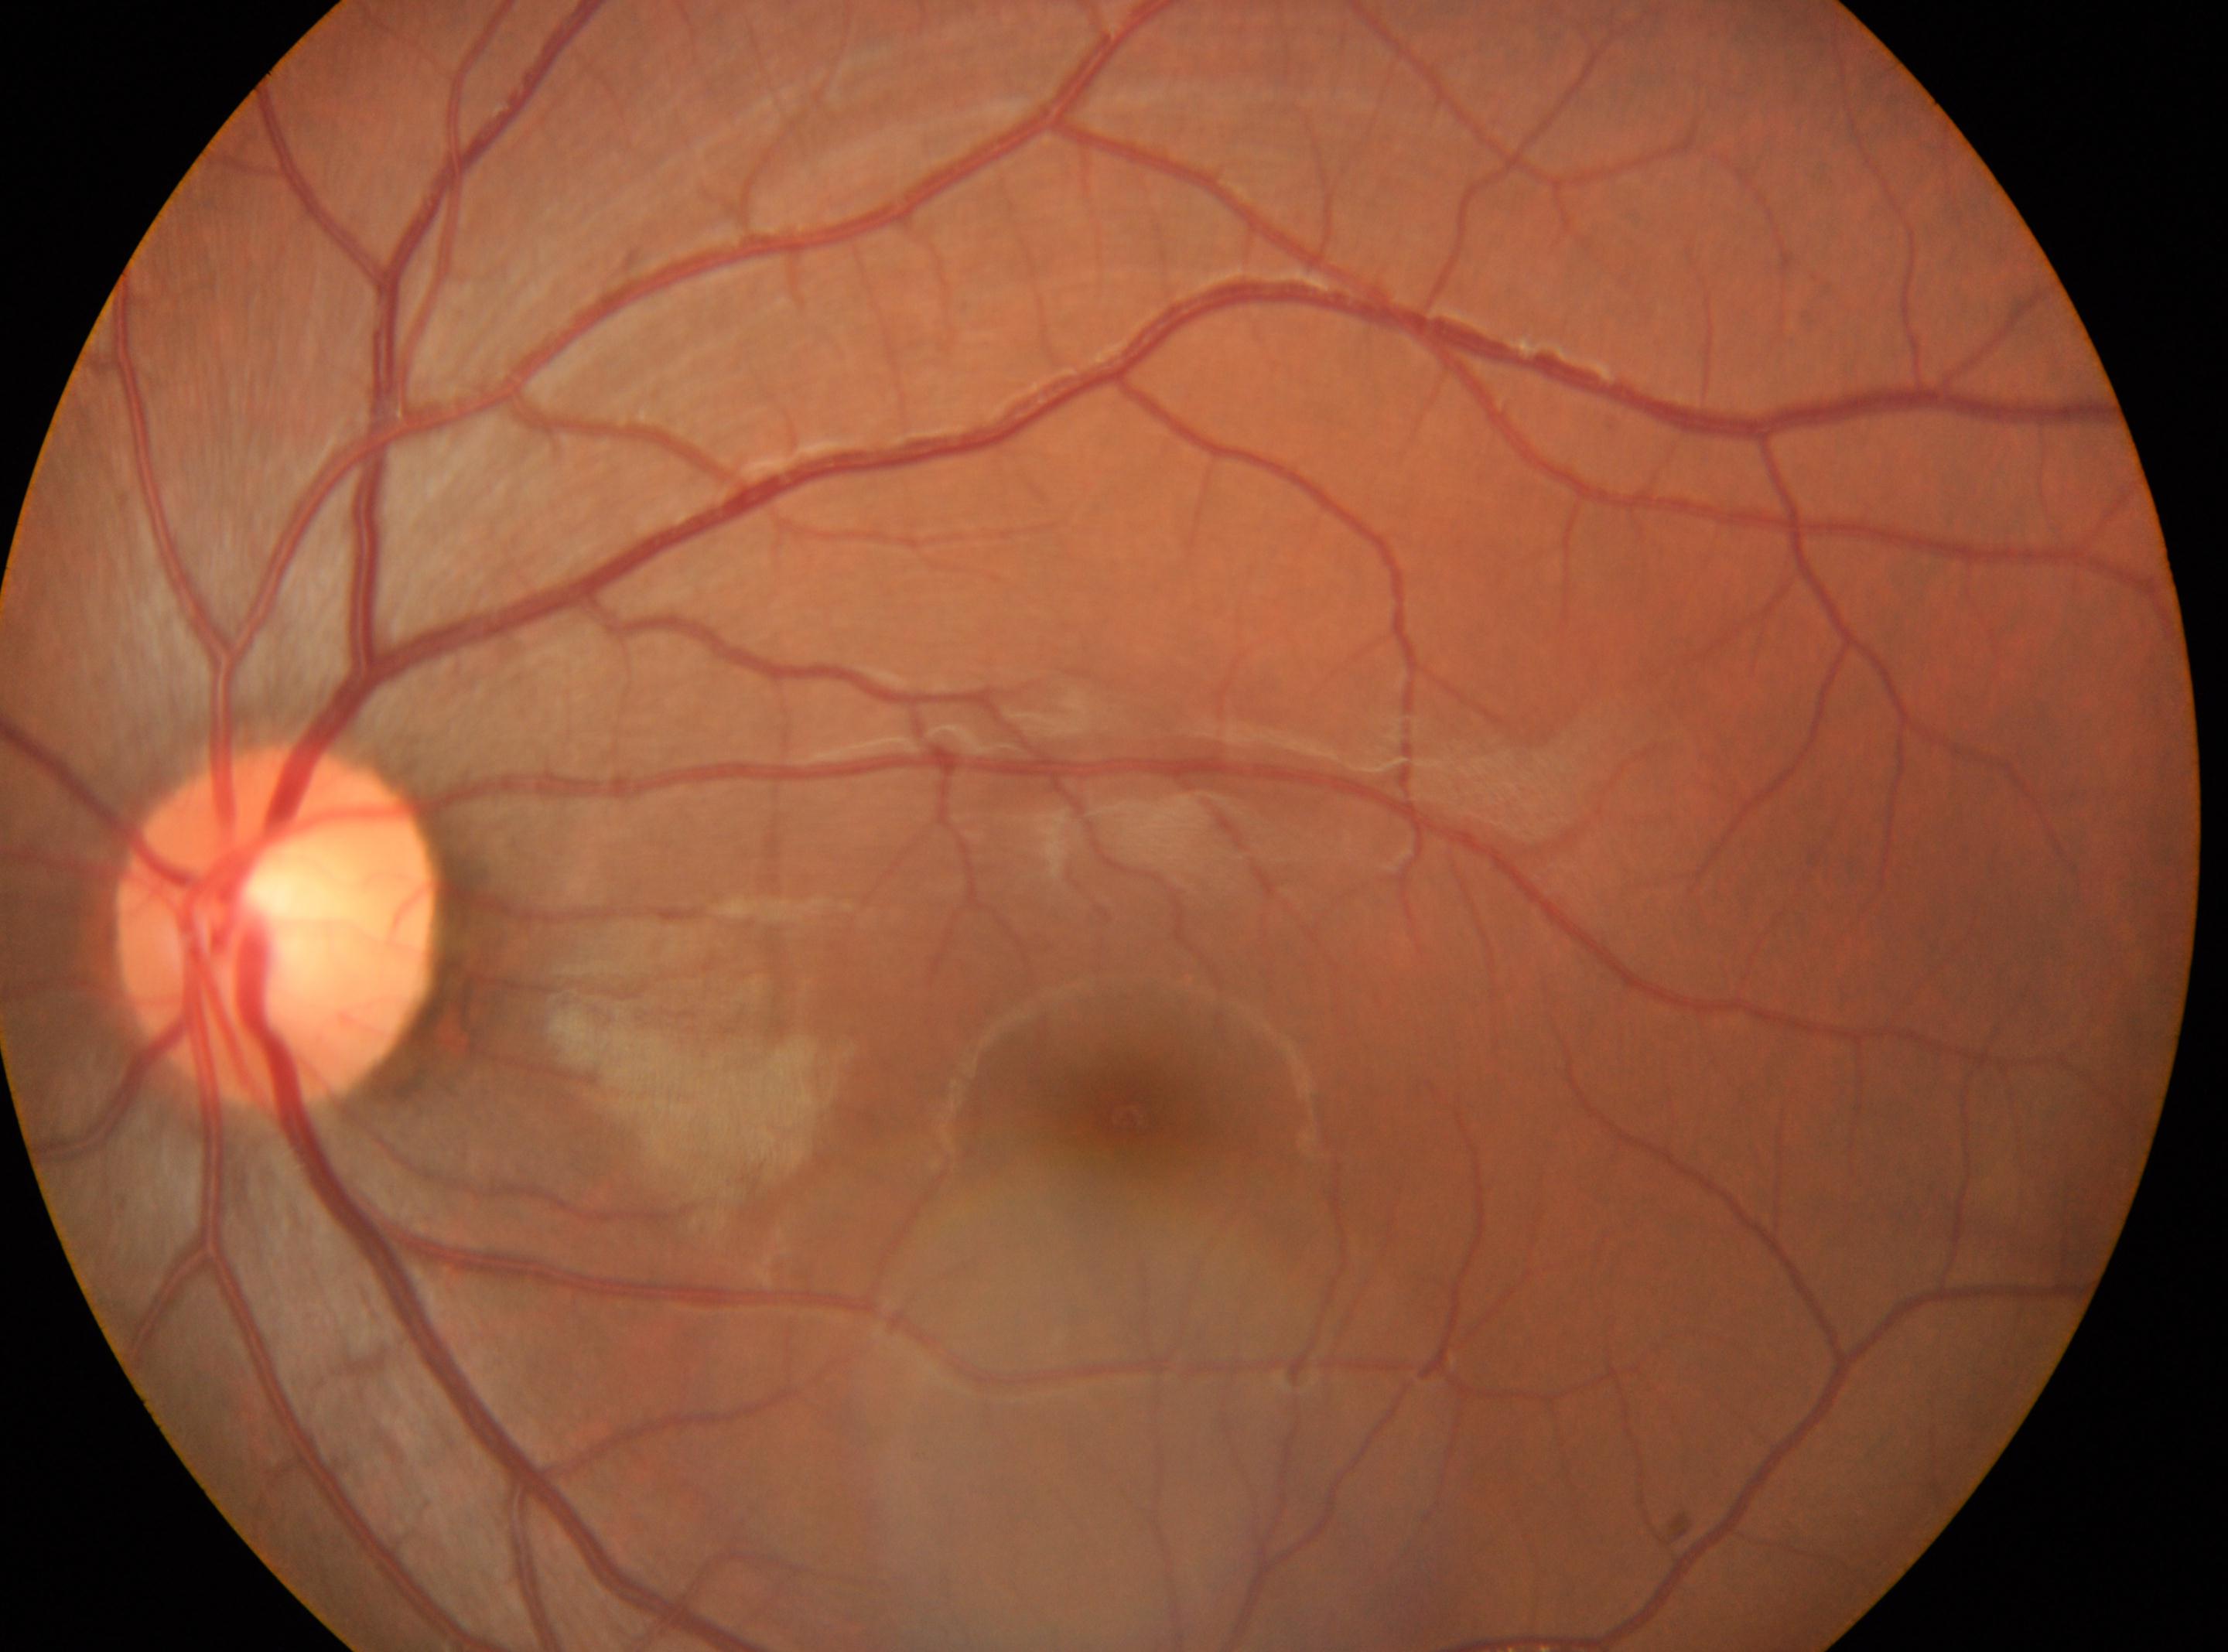
{"fovea": "(1129, 1117)", "dr_impression": "No diabetic retinal disease findings", "optic_disc": "(275, 930)", "eye": "the left eye", "dr_grade": "0/4"}